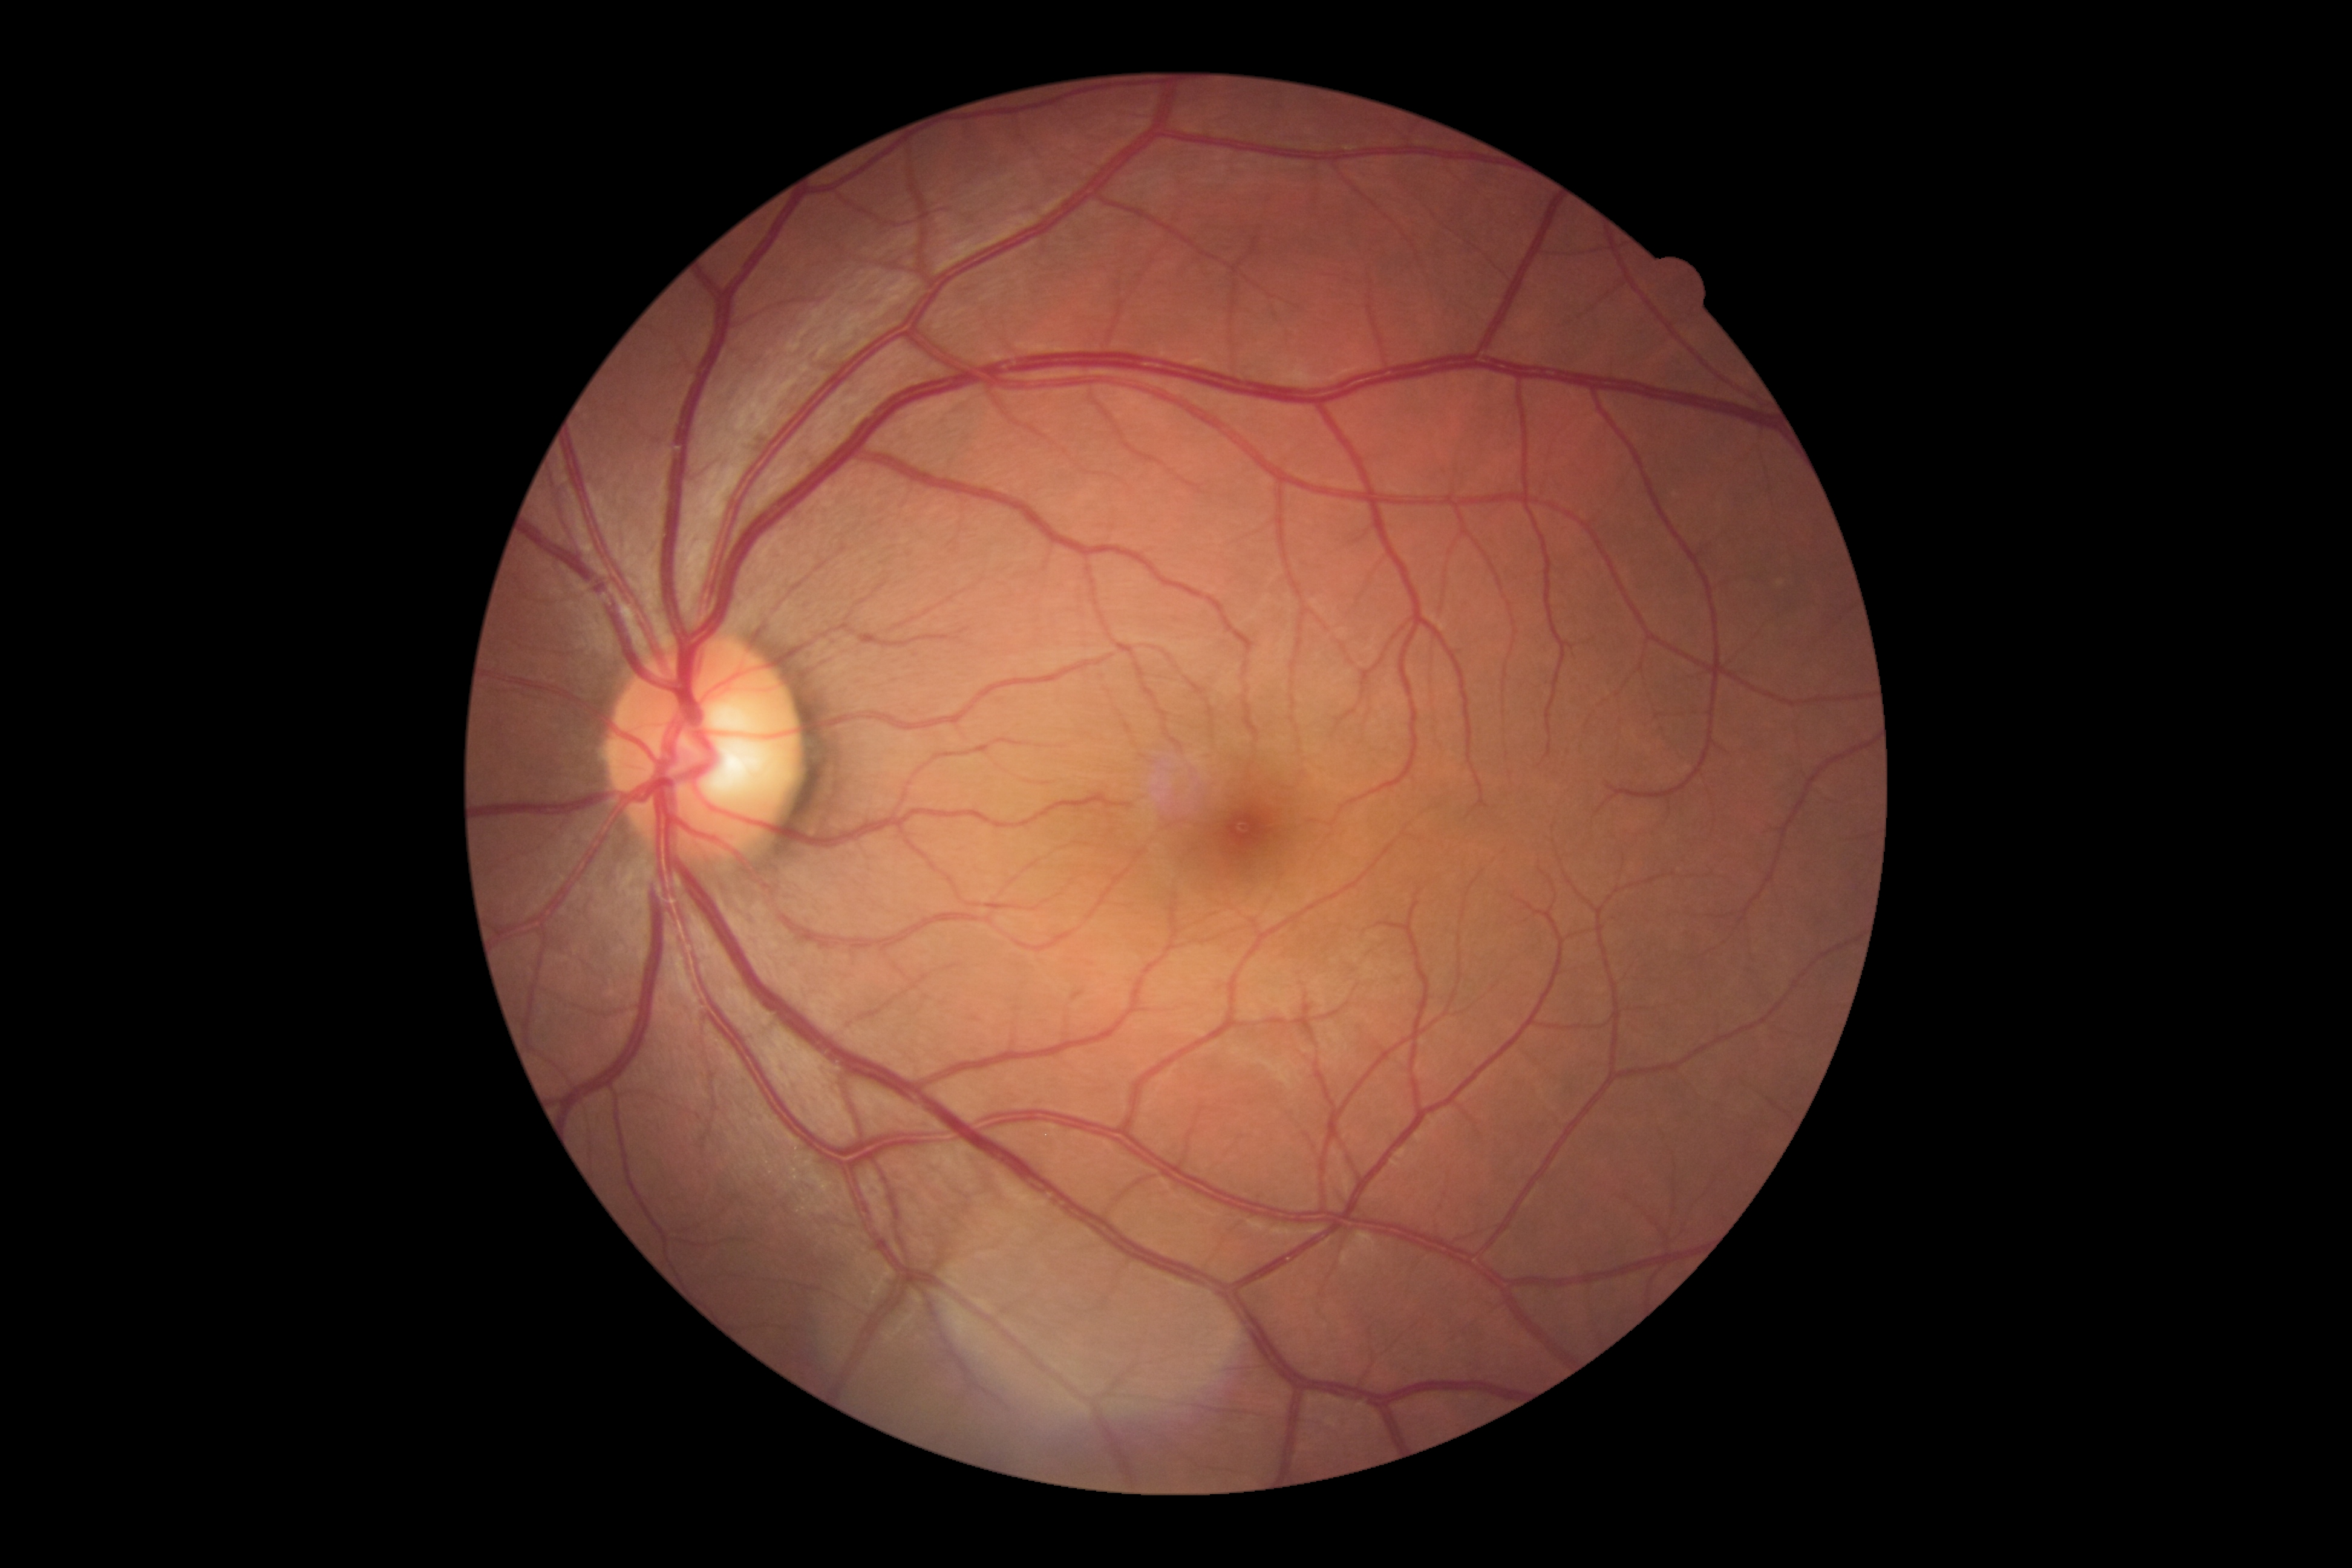

Retinopathy: no apparent retinopathy (grade 0).
No apparent diabetic retinopathy.